Infant wide-field retinal image — 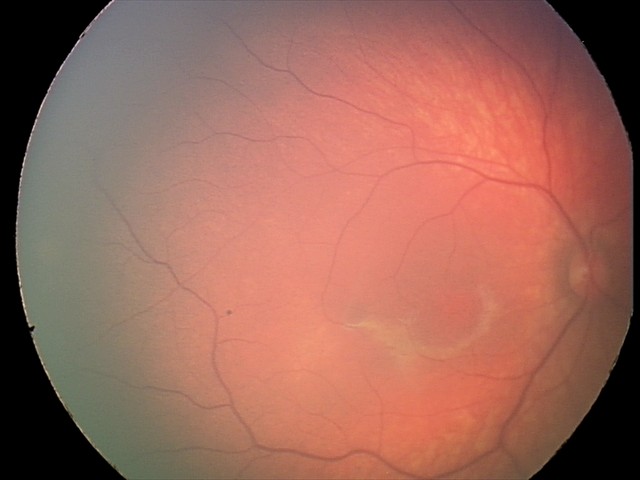

Assessment = retinal hemorrhages.